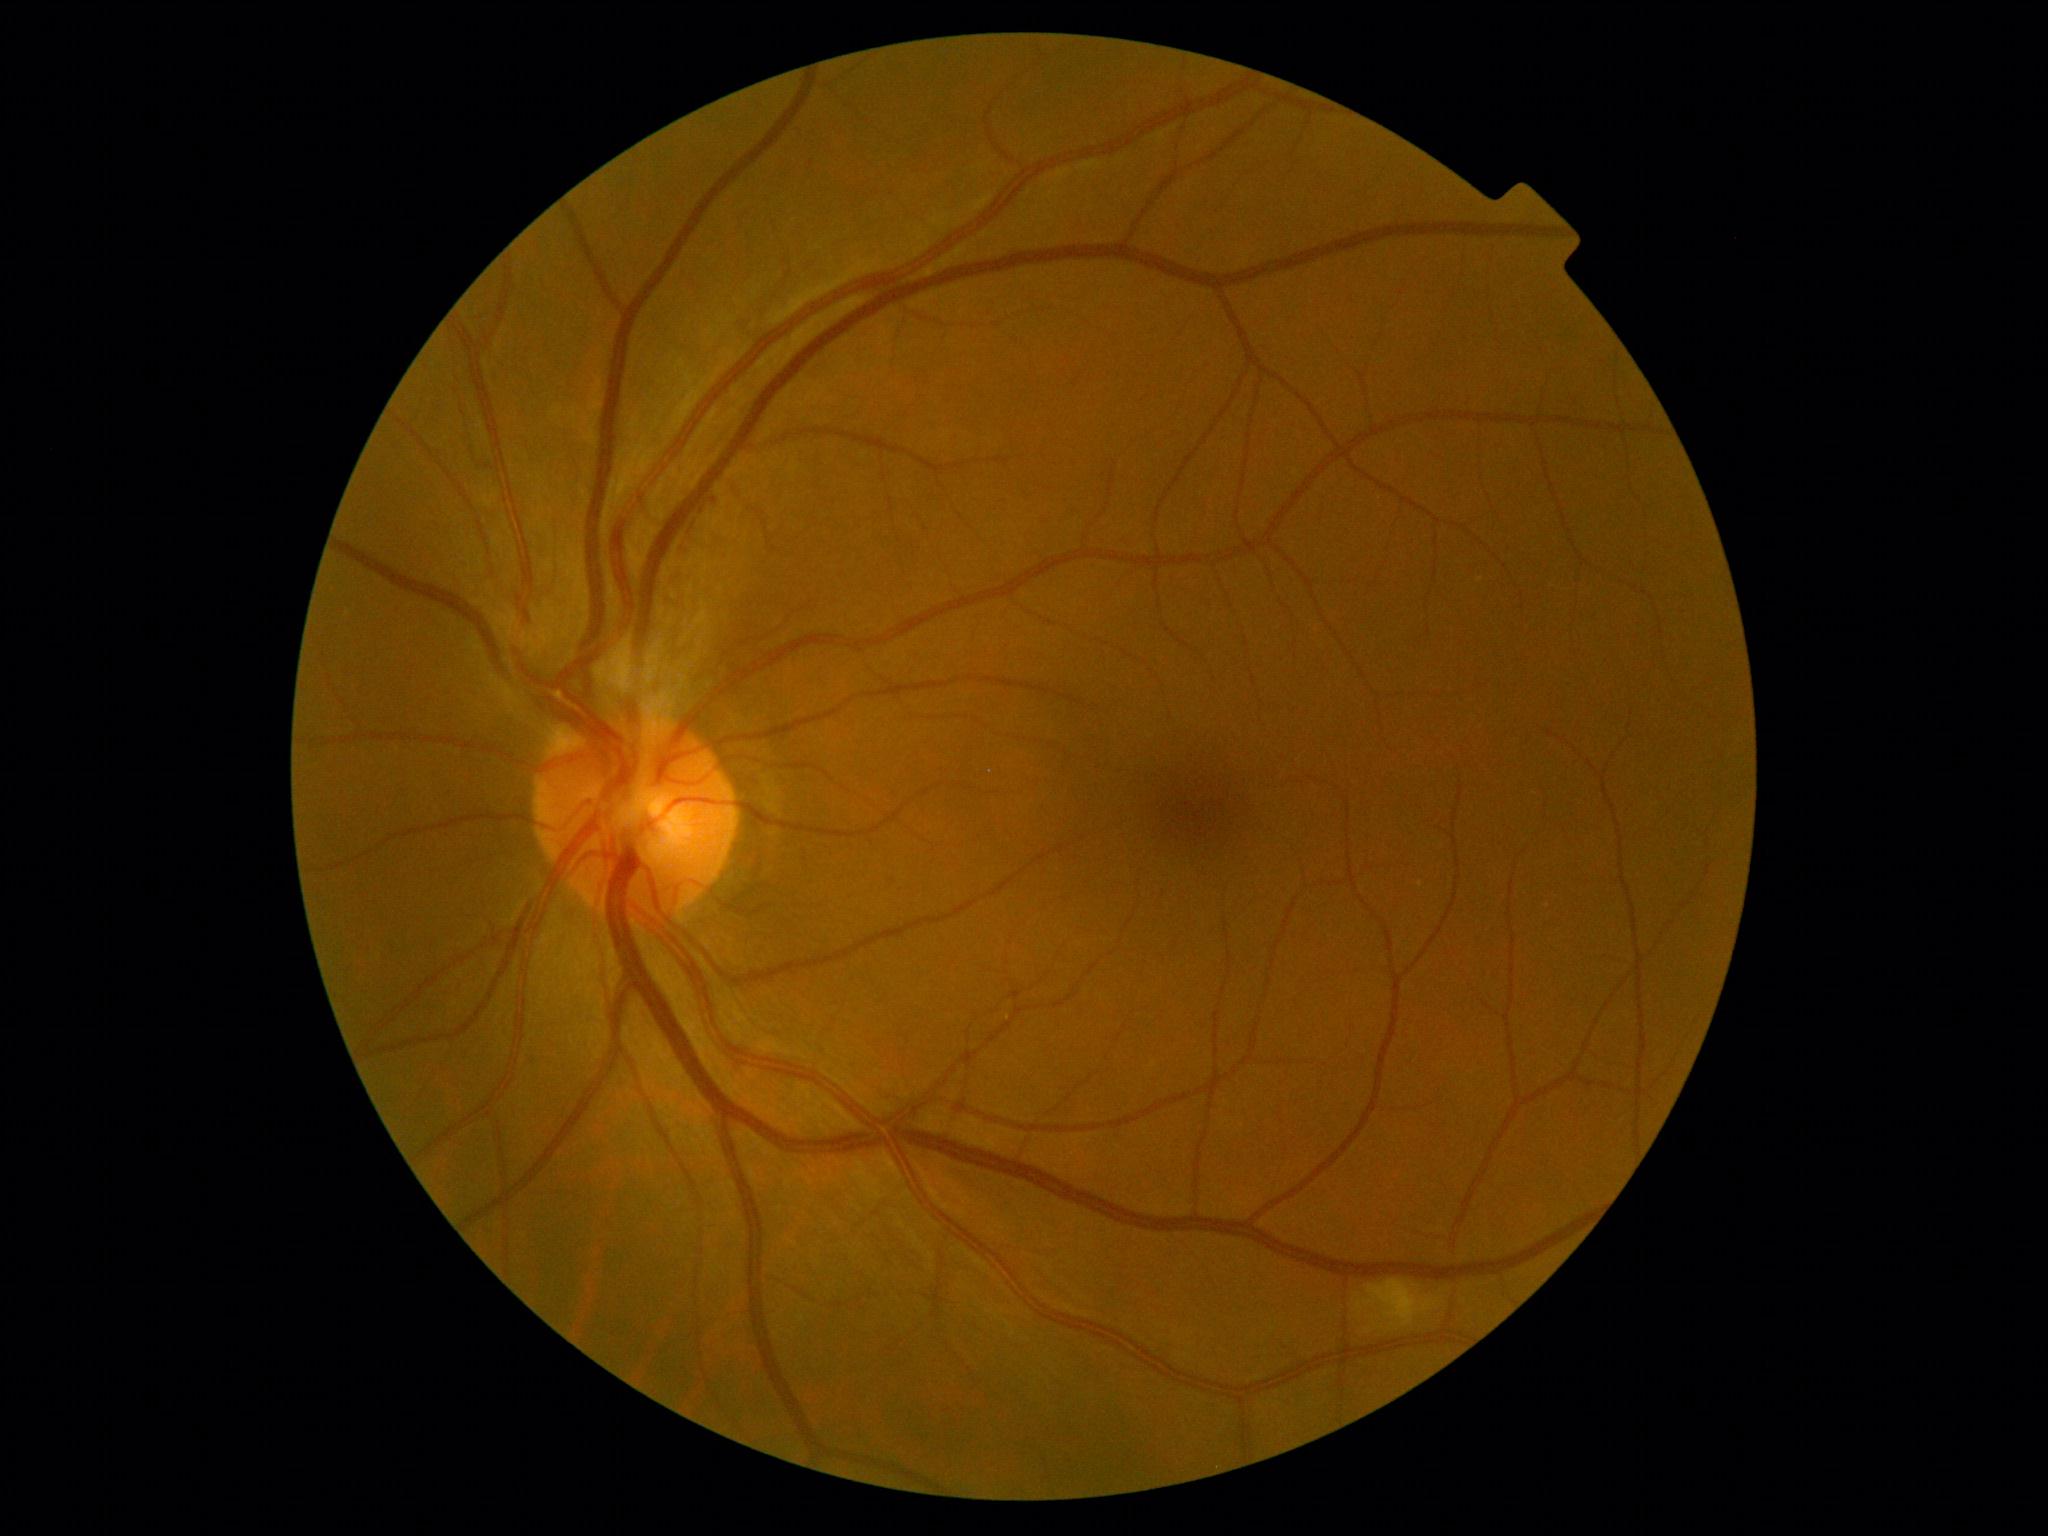
diabetic retinopathy grade: moderate non-proliferative diabetic retinopathy (2).